Fundus photo · 45° FOV · camera: NIDEK AFC-230 — 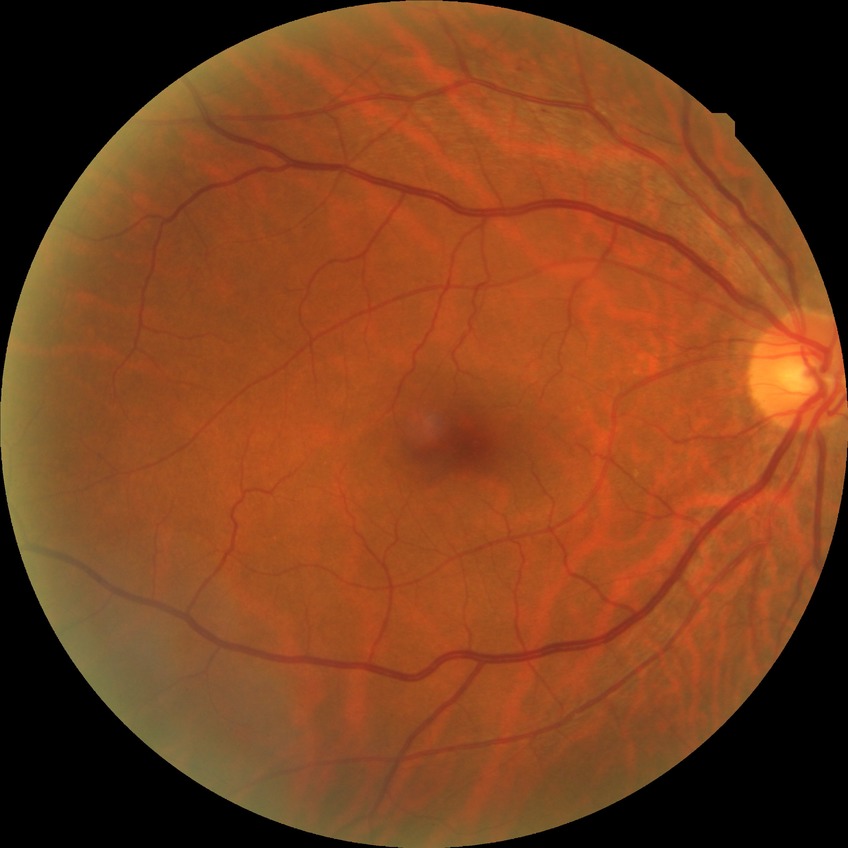 {
  "davis_grade": "NDR (no diabetic retinopathy)"
}